Acquired with a NIDEK AFC-230 · without pupil dilation.
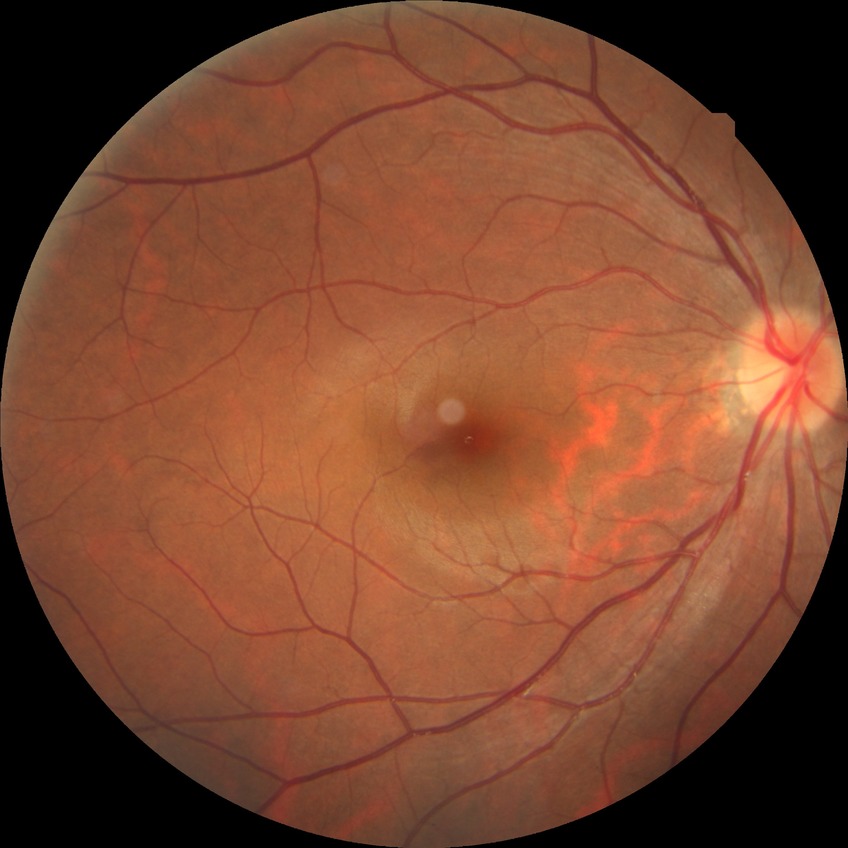
diabetic retinopathy (DR) = no diabetic retinopathy (NDR).